Pediatric wide-field fundus photograph; 130° field of view (Clarity RetCam 3)
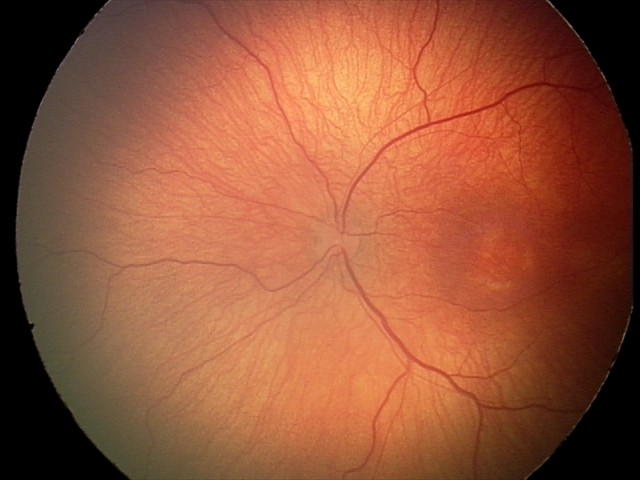
Assessment: no plus disease; retinopathy of prematurity stage 2.